45° FOV
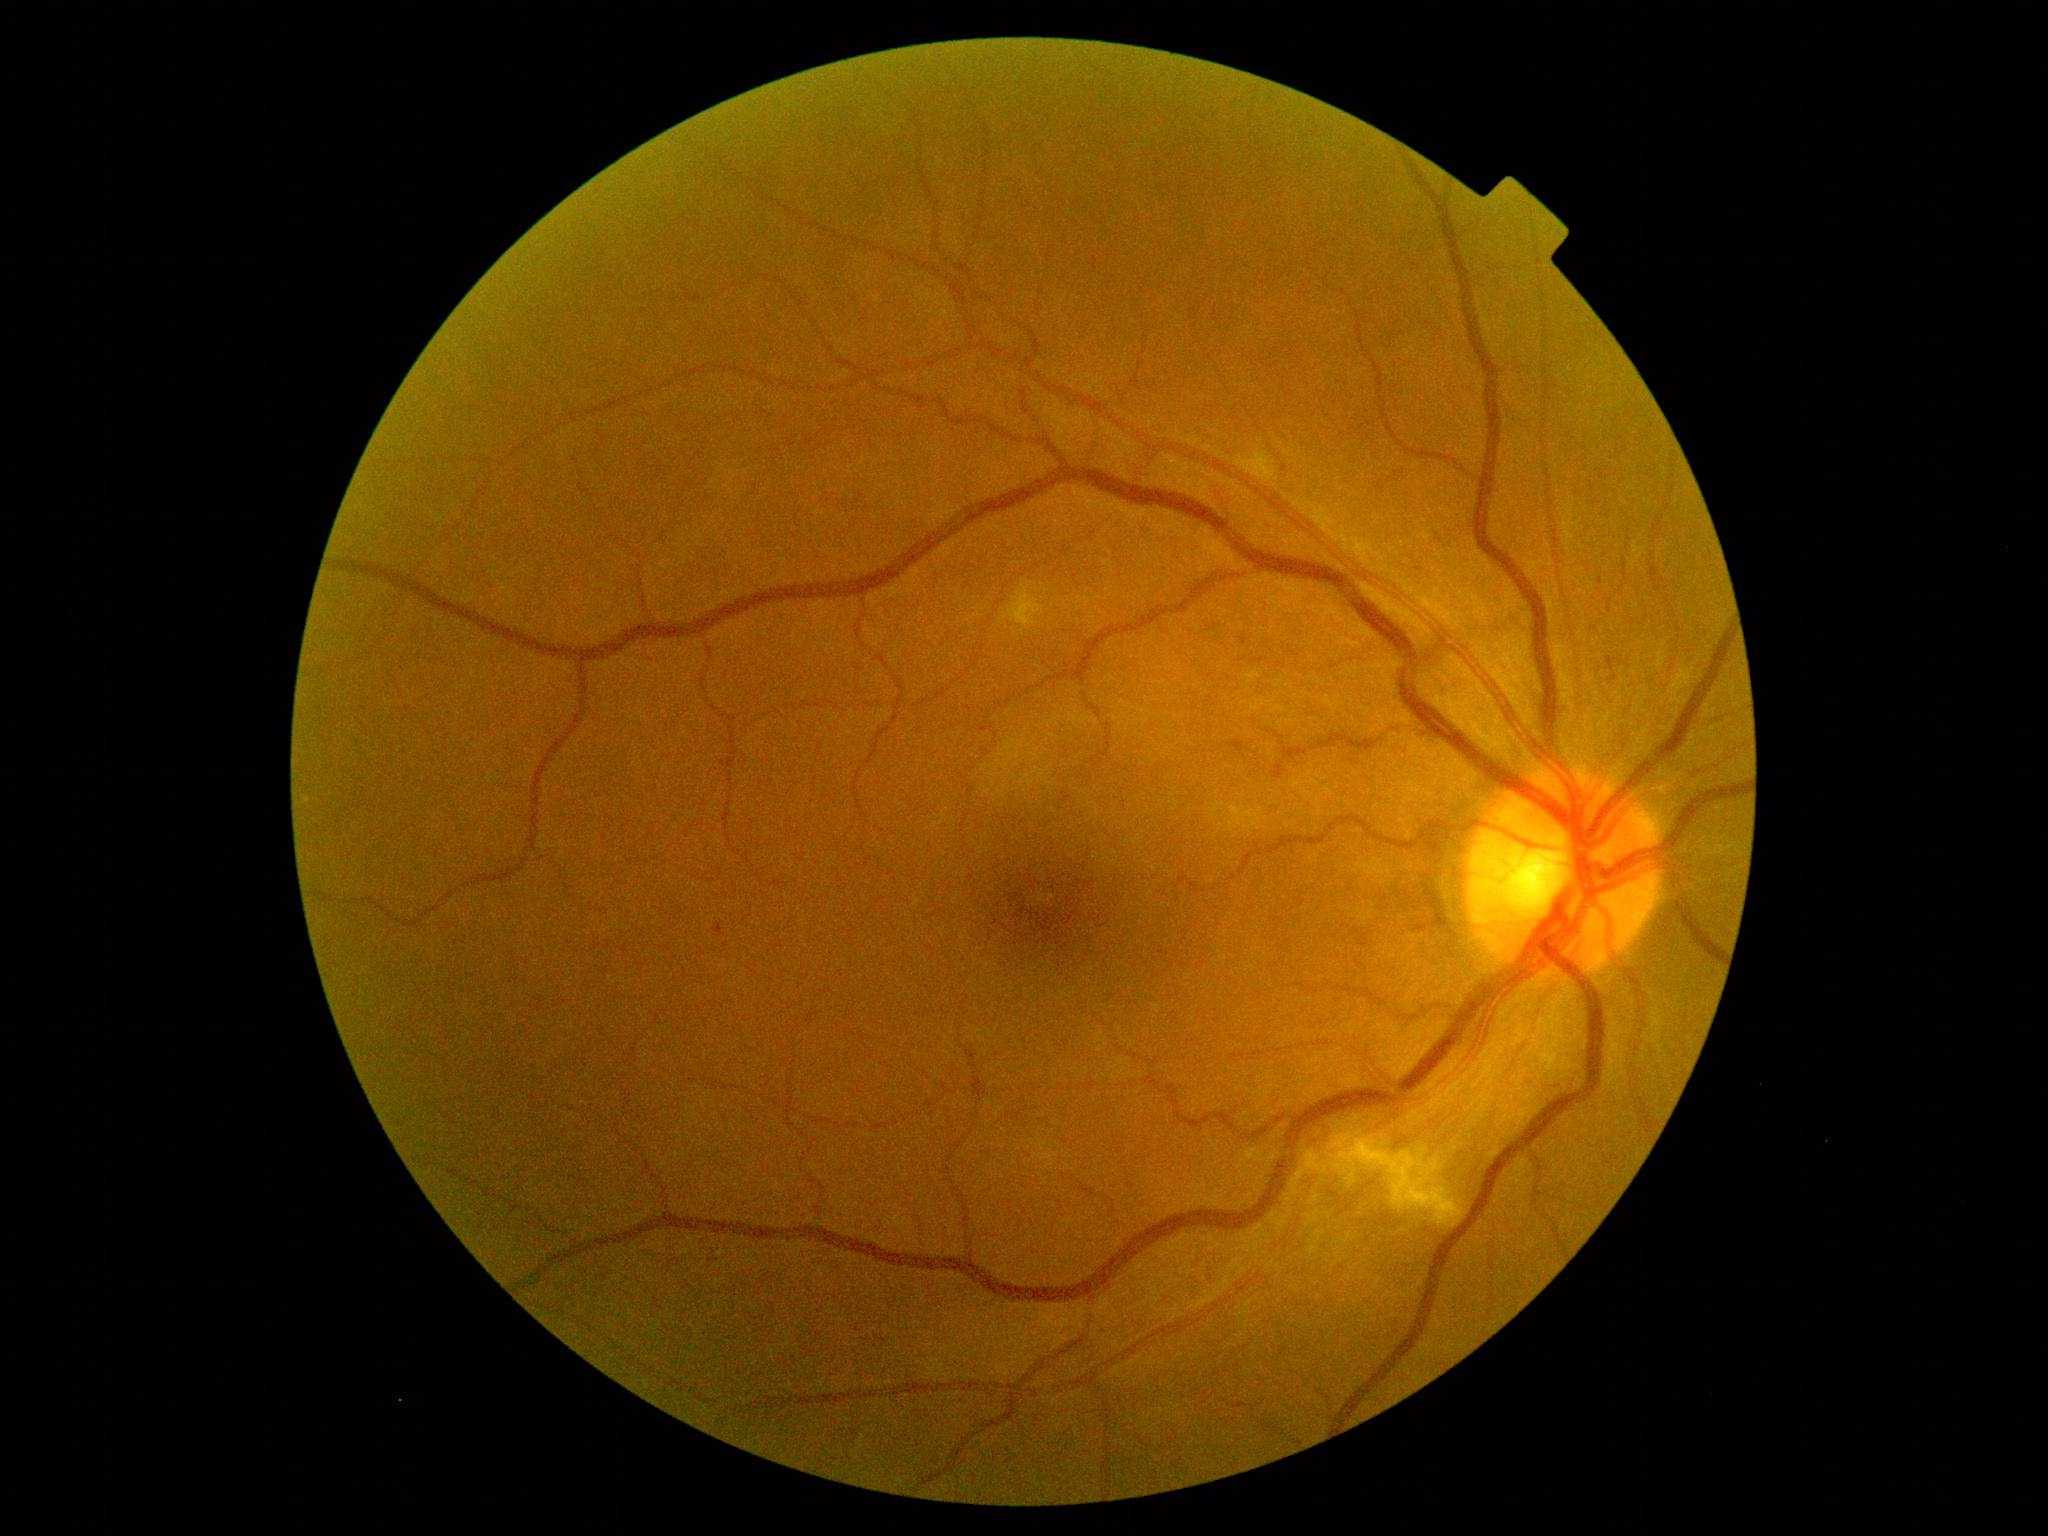
dr_grade: grade 2 (moderate NPDR)